640x480px; pediatric wide-field fundus photograph; camera: Clarity RetCam 3 (130° FOV): 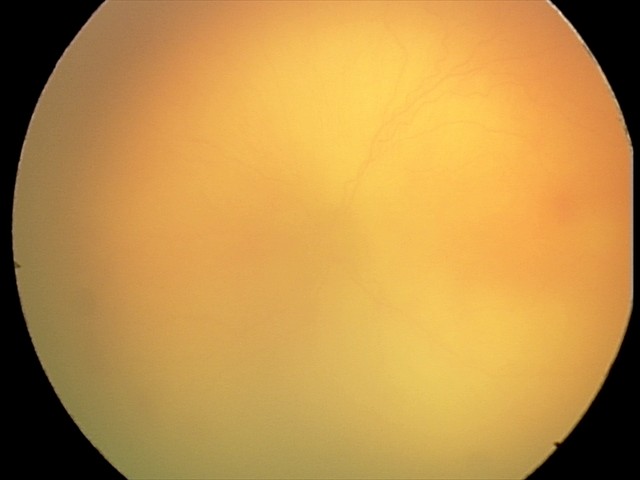
Screening diagnosis = aggressive retinopathy of prematurity (A-ROP) — rapidly progressive severe ROP with prominent plus disease, often without classic stage progression | plus form = present — abnormal dilation and tortuosity of the posterior pole retinal vessels.